Nonmydriatic fundus photograph · modified Davis grading:
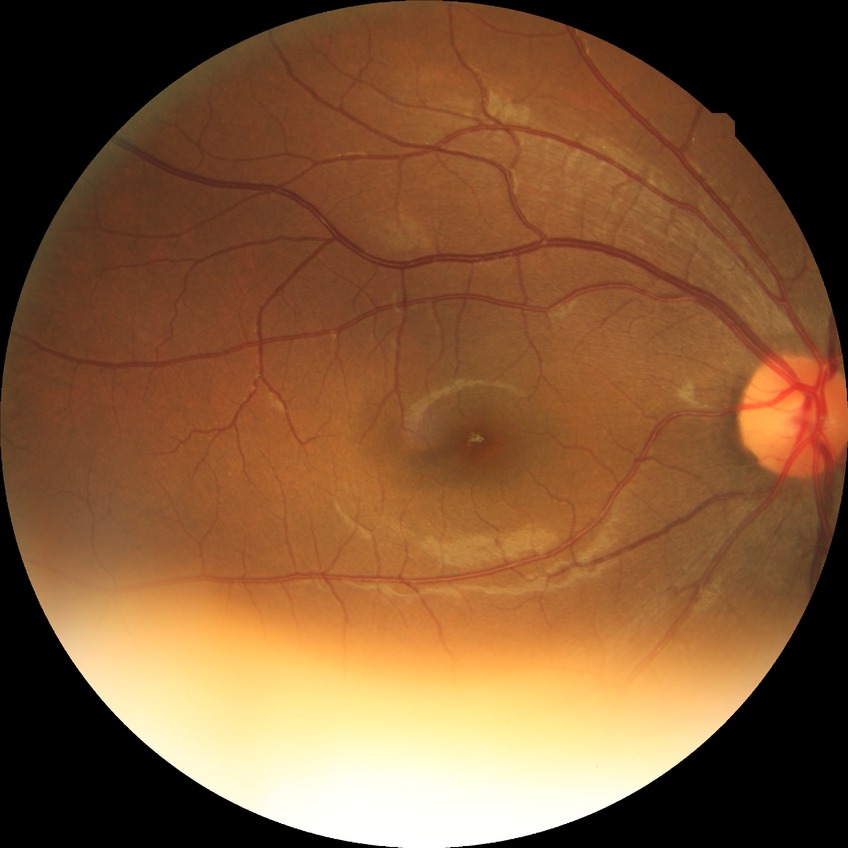 diabetic retinopathy stage: no diabetic retinopathy.